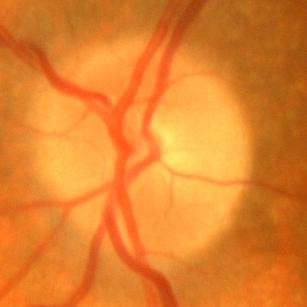 Glaucoma status: no evidence of glaucoma.